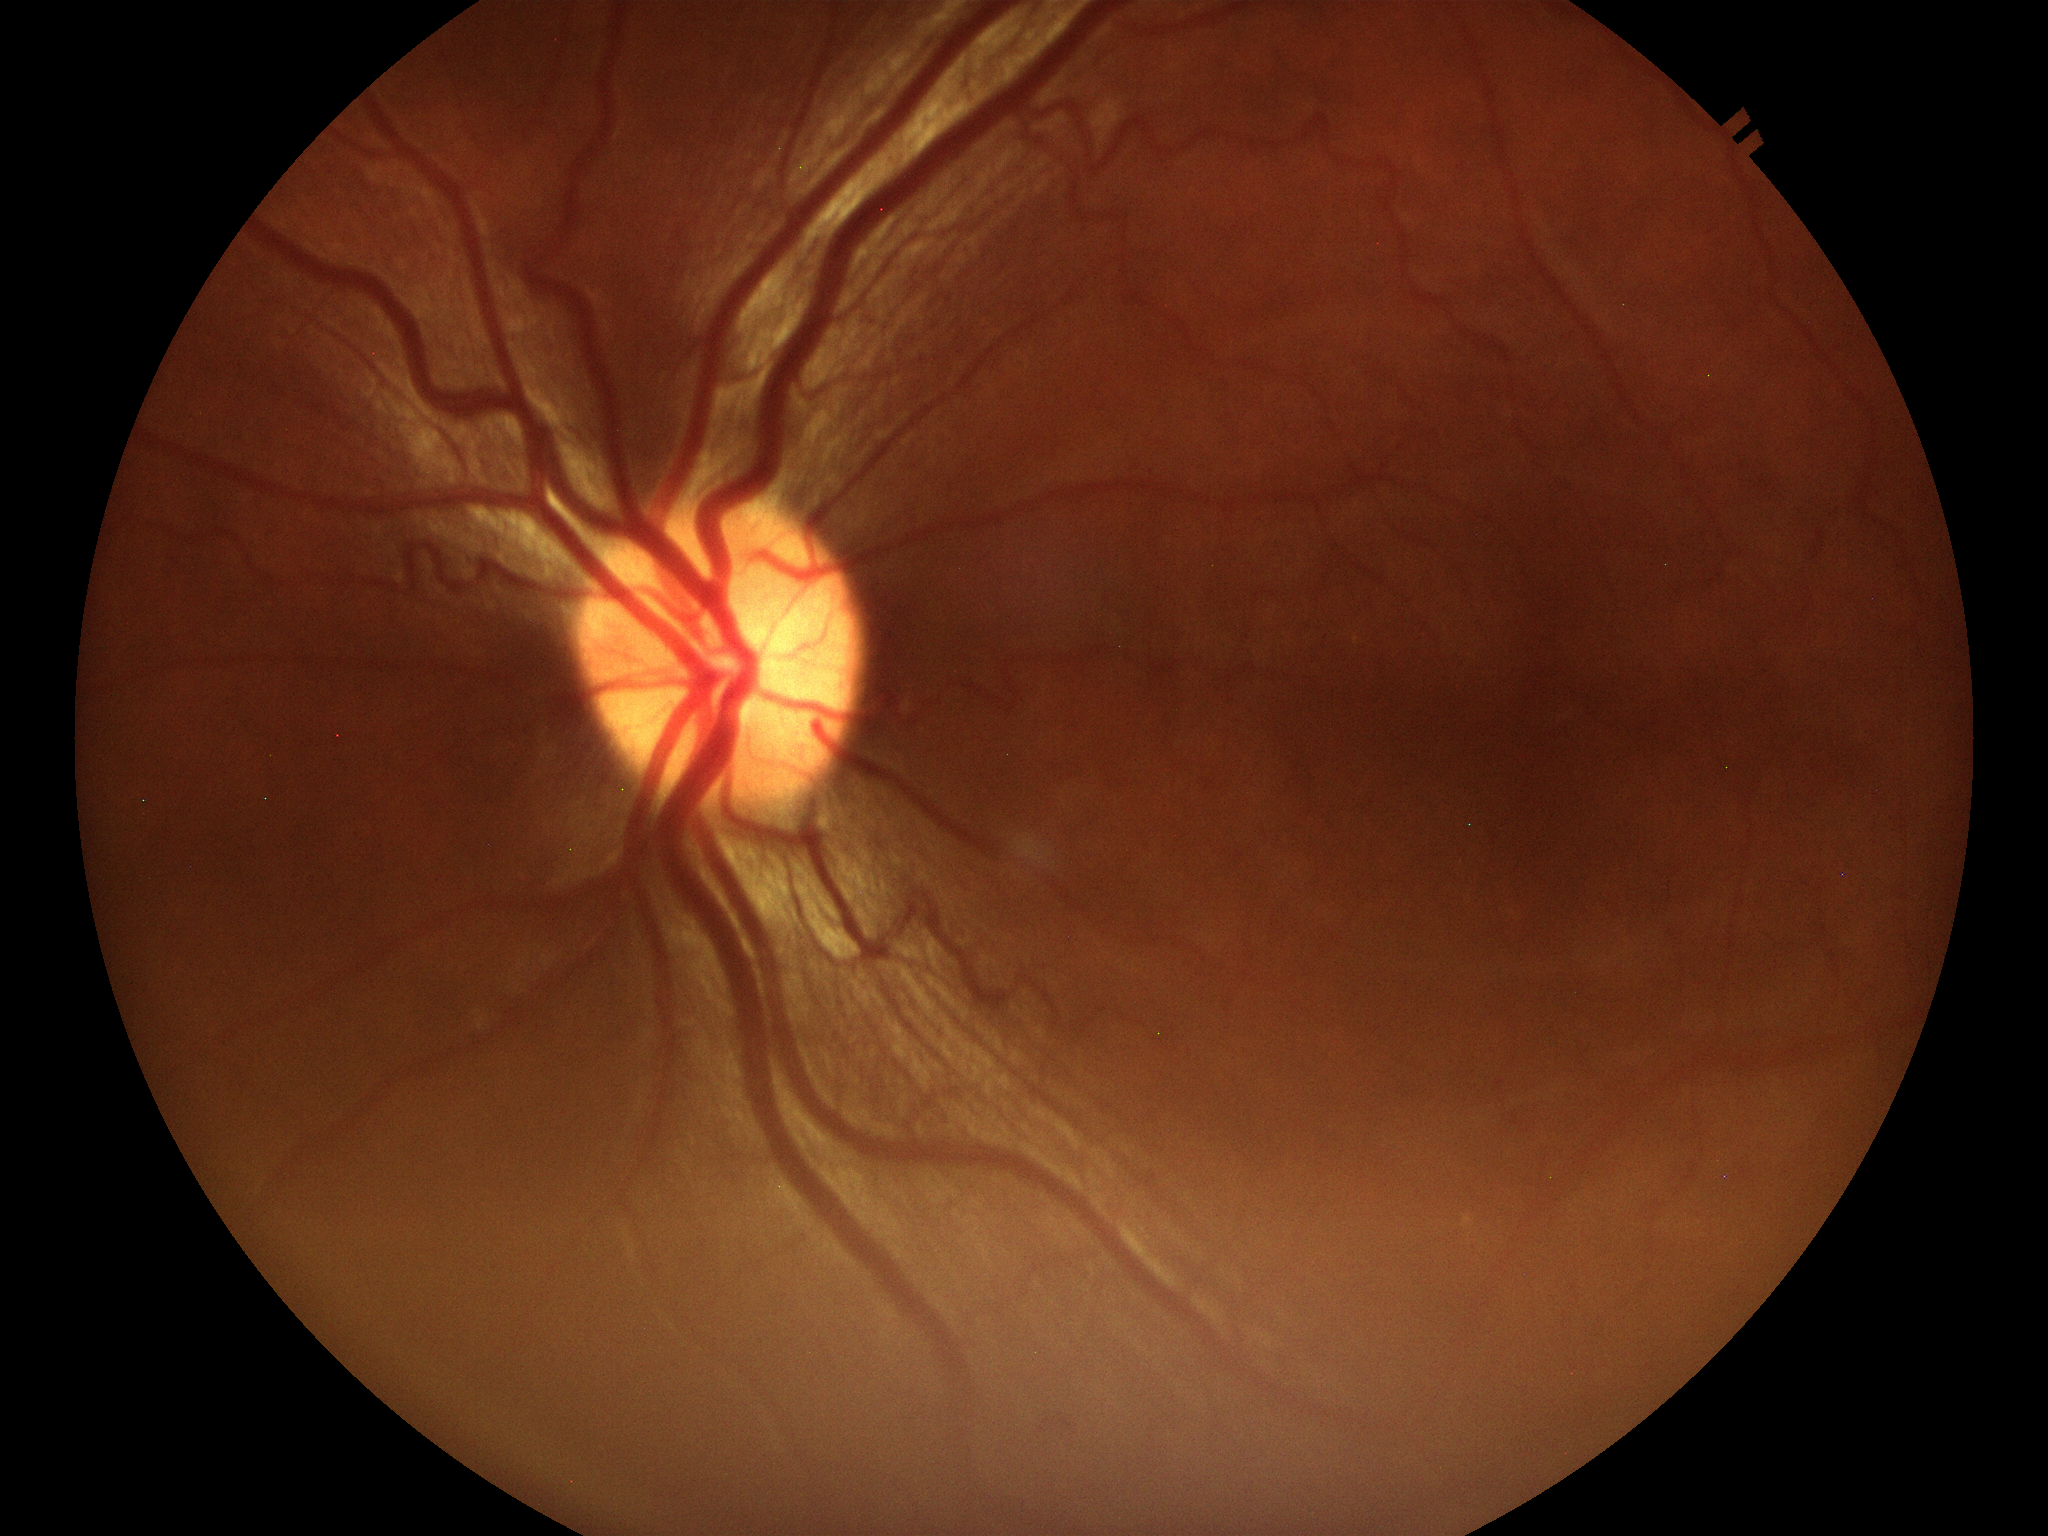

Negative for glaucoma suspicion. Horizontal C/D ratio of 0.51. Vertical C/D ratio is 0.49.